45-degree field of view
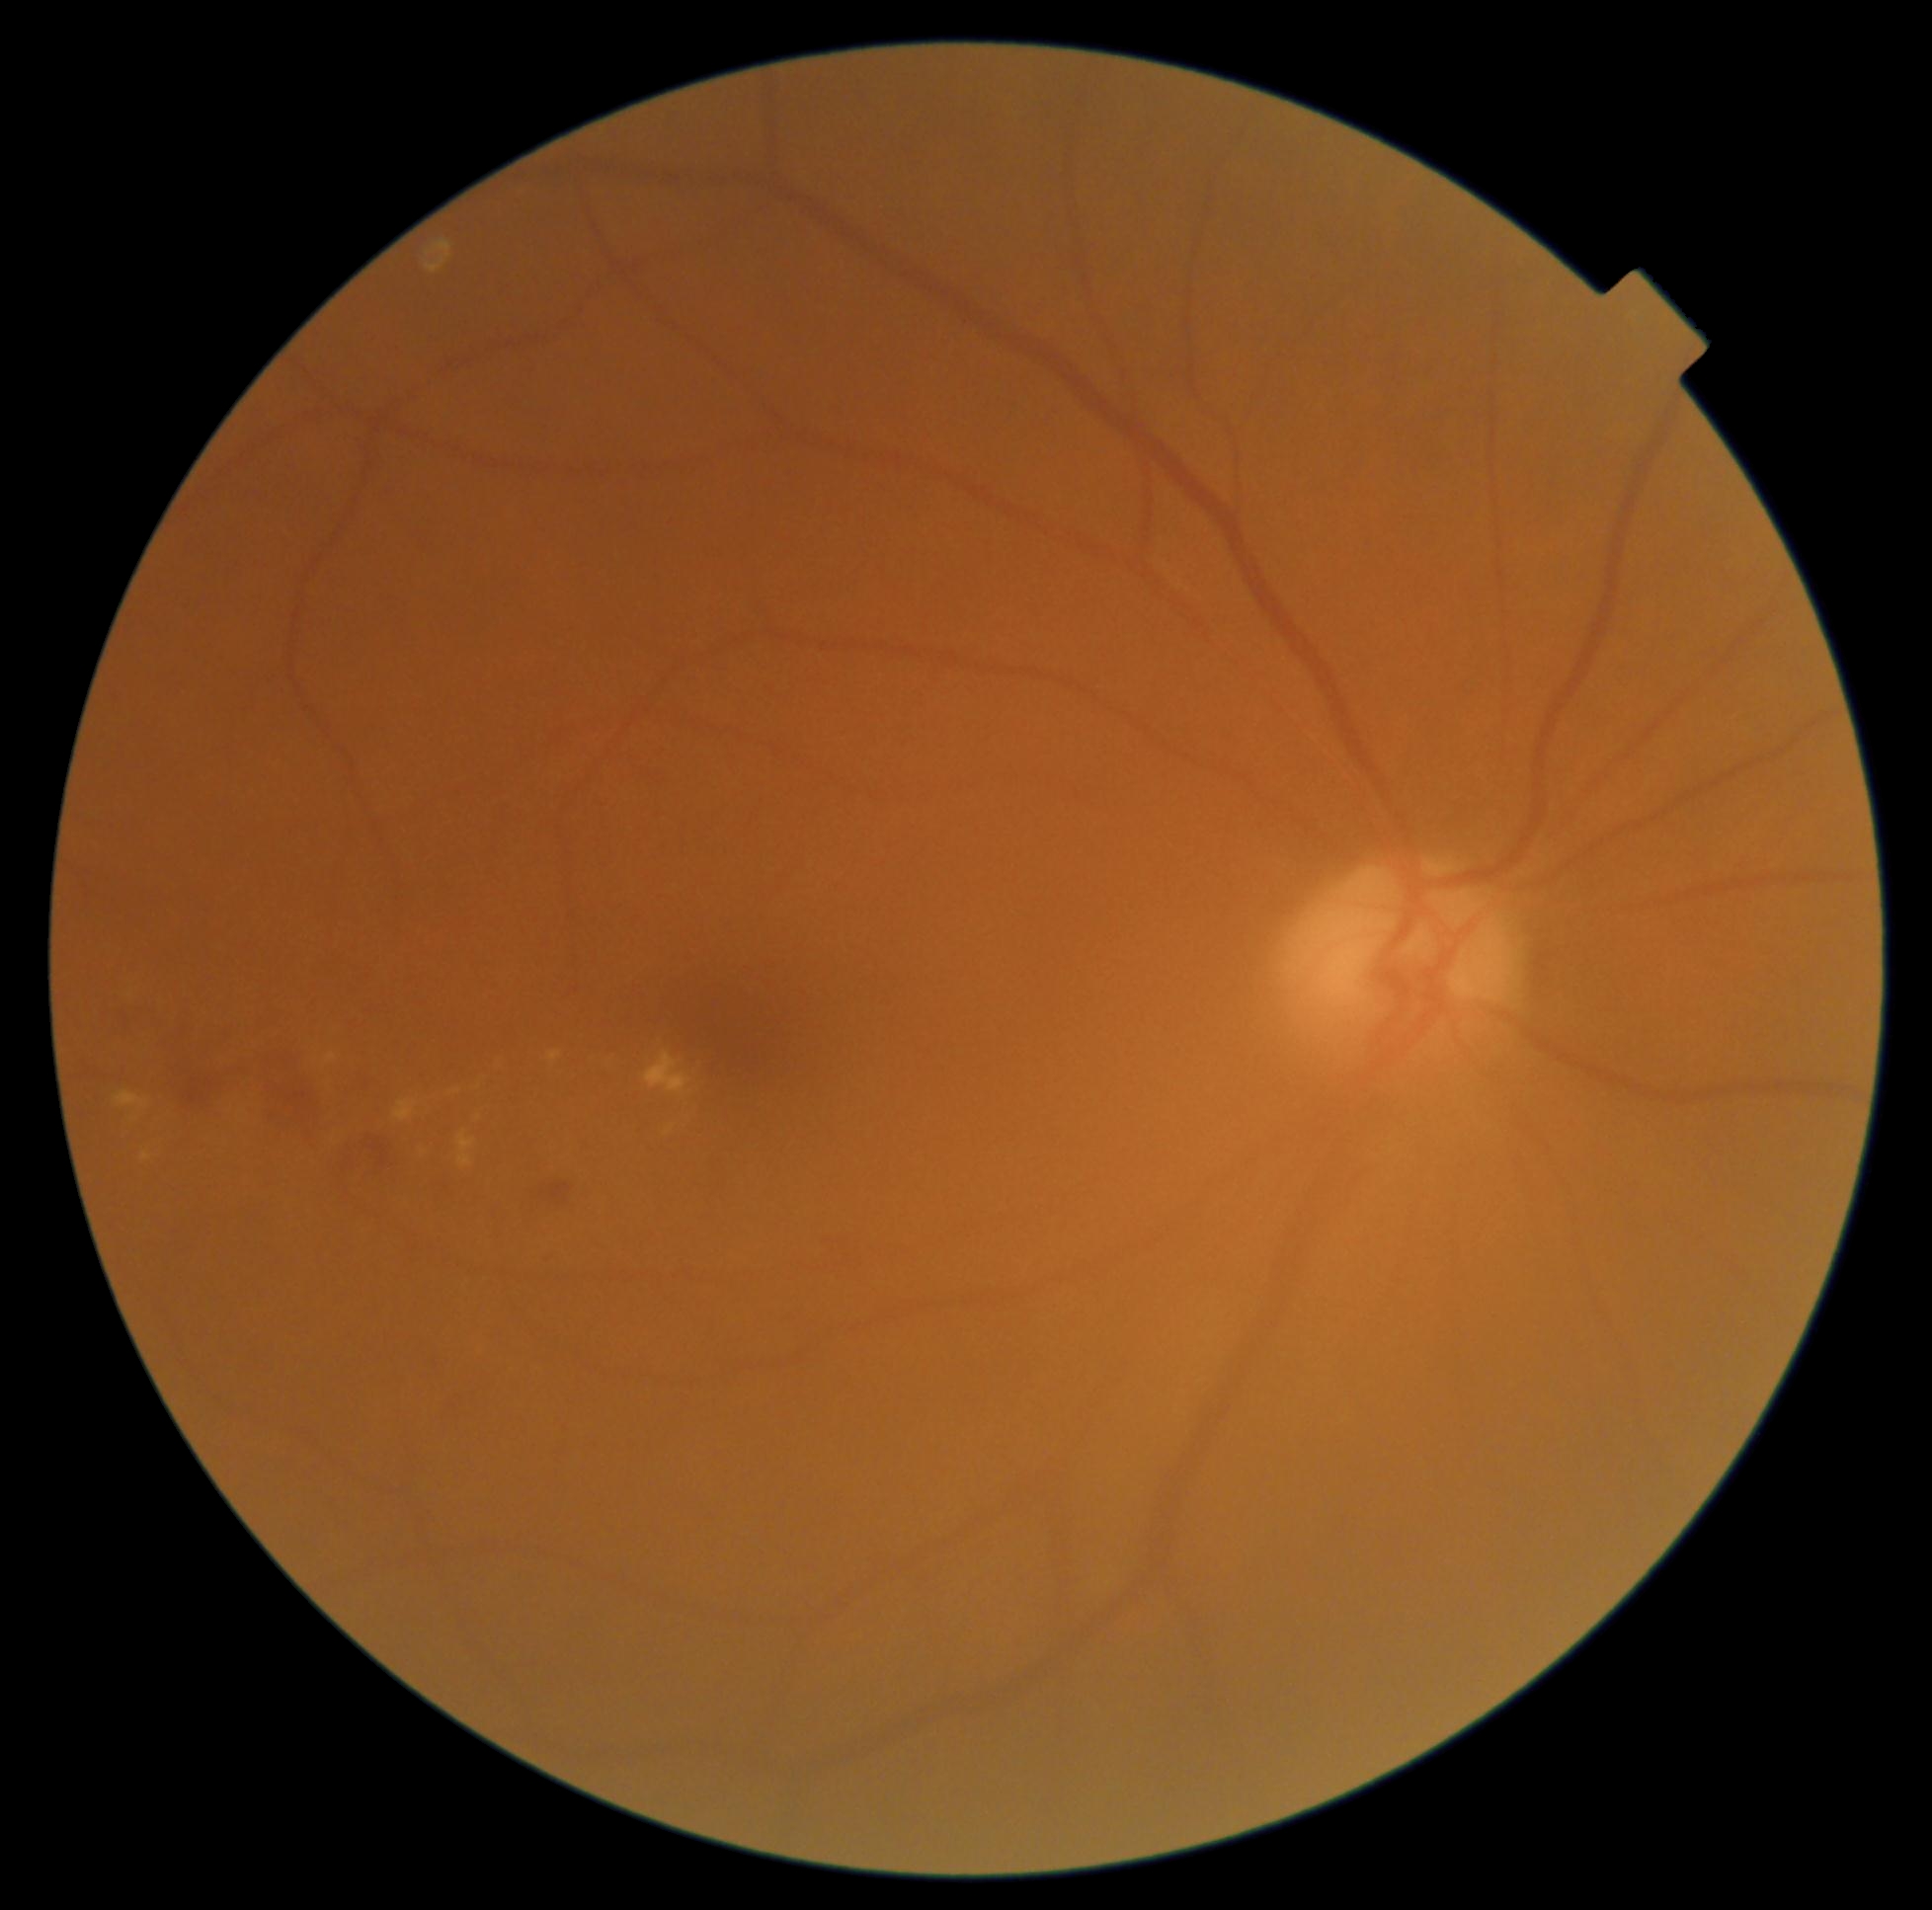

{"partial":true,"dr_grade":2,"lesions":{"he":[[171,1051,221,1113],[343,1121,404,1185],[443,1130,499,1216],[540,1183,574,1207],[115,998,145,1038],[262,1045,325,1130]],"se":null,"ma":null,"ex":[[666,1128,673,1137],[644,1053,692,1097],[327,1054,338,1064],[457,1133,477,1169],[142,1153,153,1161],[395,1101,418,1123],[549,1053,562,1062],[115,1092,149,1110]],"ex_small_approx":[[459,1091],[479,1119]]}}